100° field of view (Phoenix ICON) · pediatric wide-field fundus photograph.
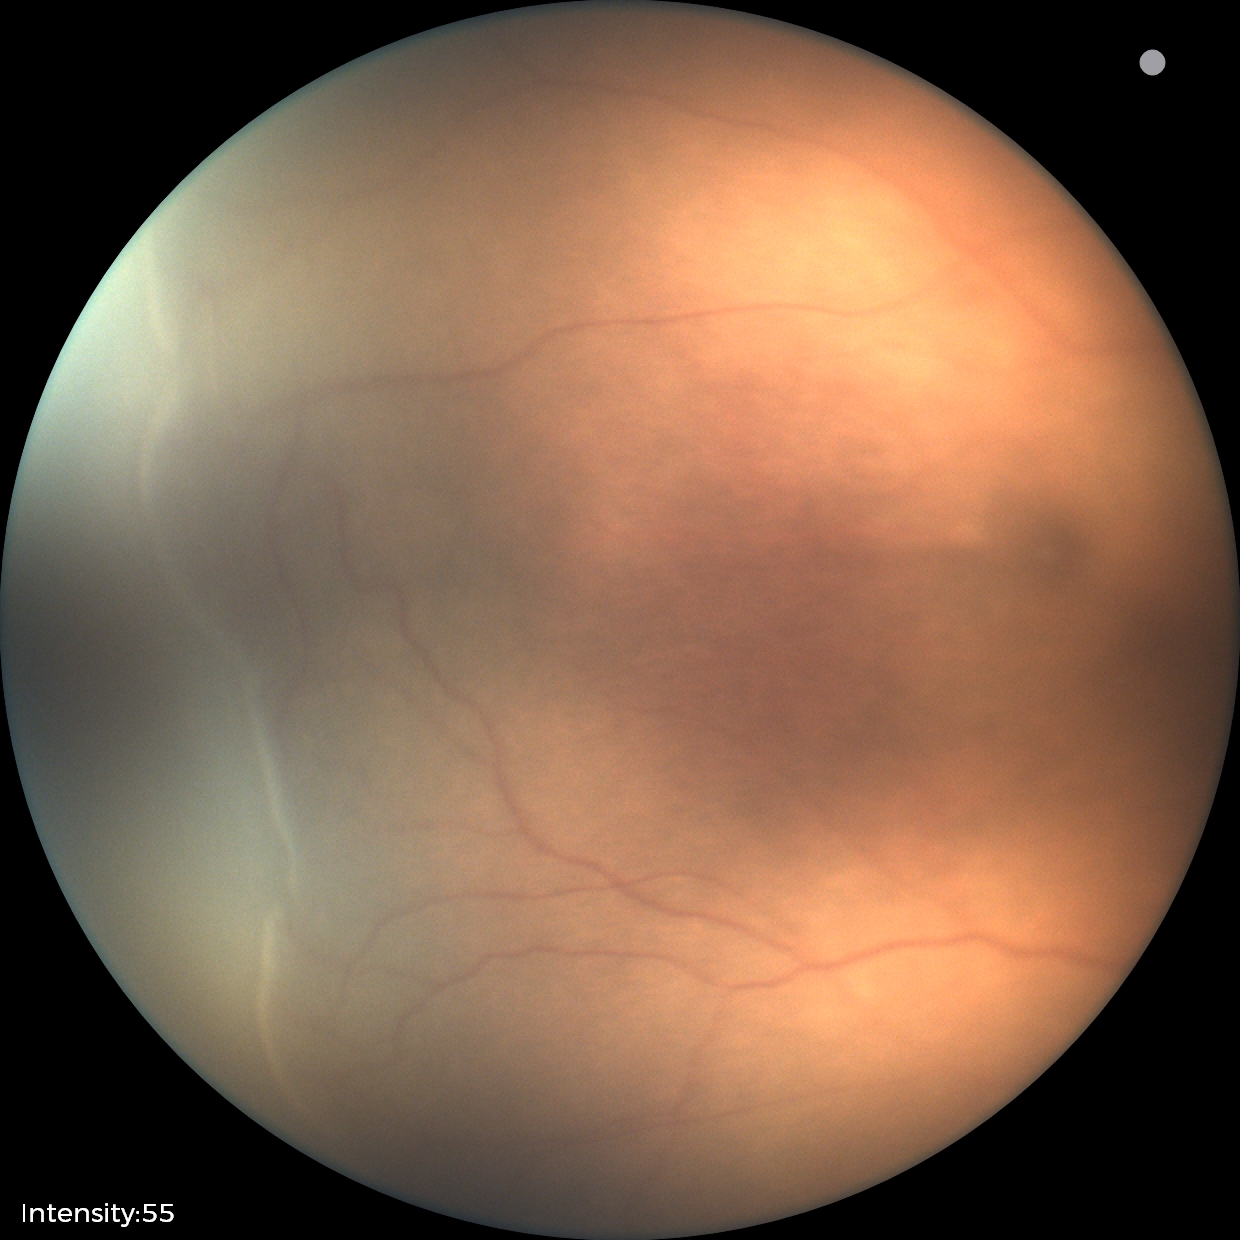

Examination diagnosed as retinopathy of prematurity stage 2.